Modified Davis classification: 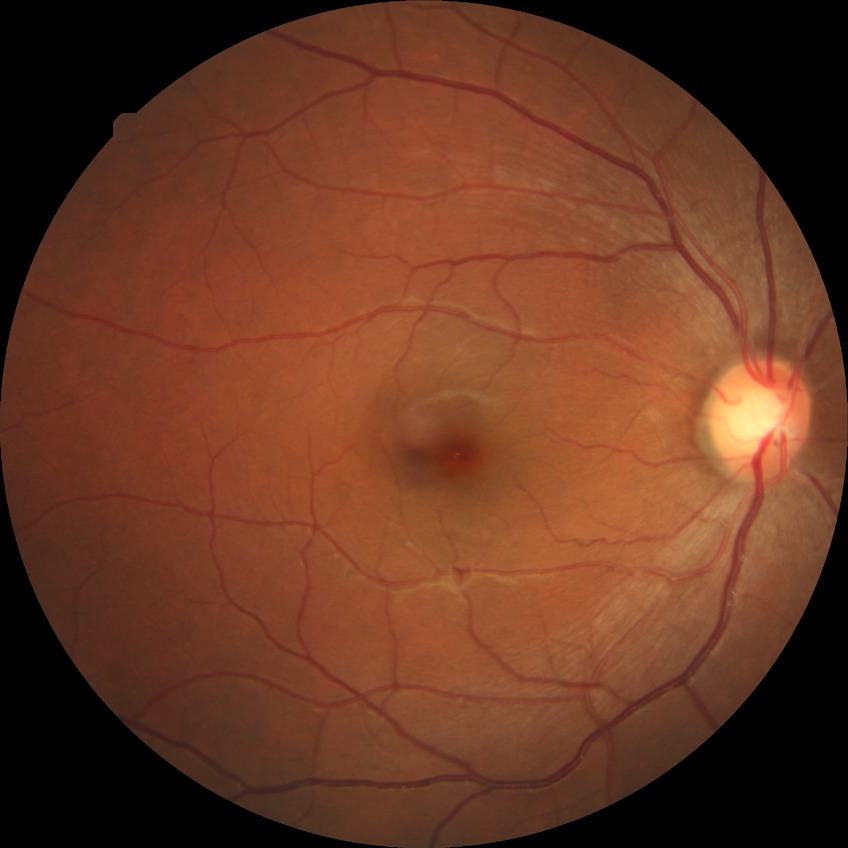 Diabetic retinopathy (DR) is NDR (no diabetic retinopathy).